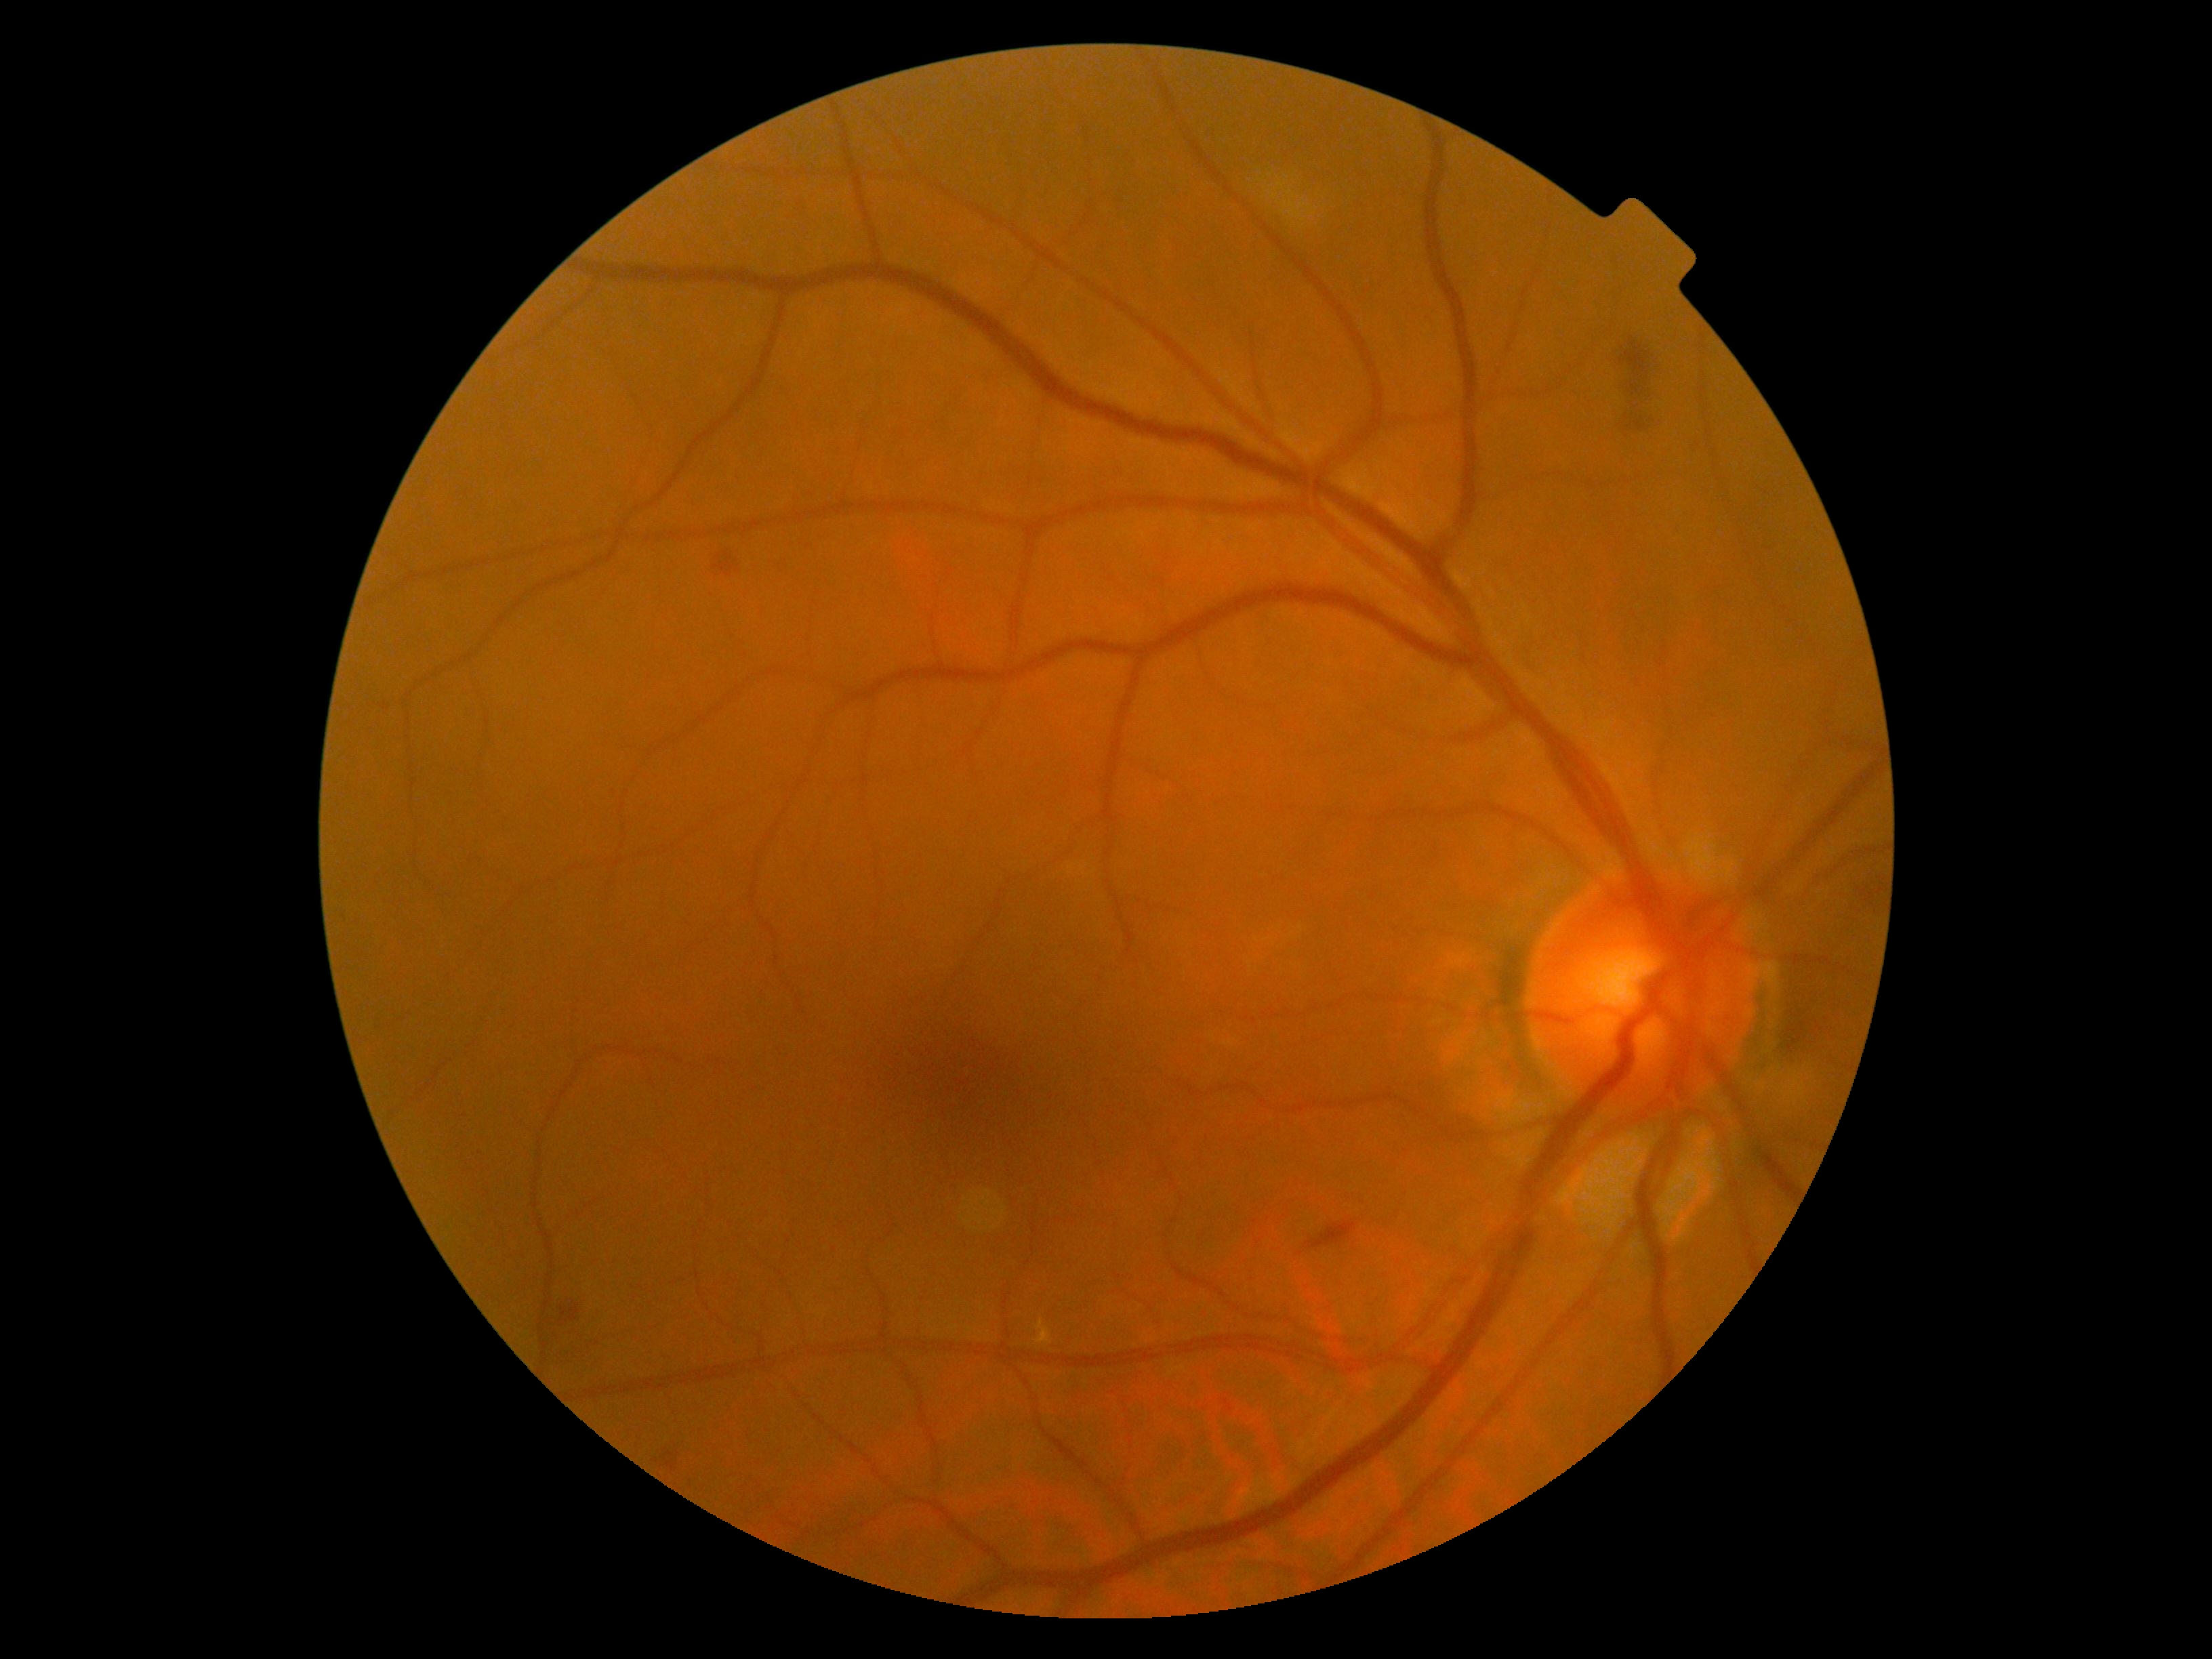
DR severity@2/4.